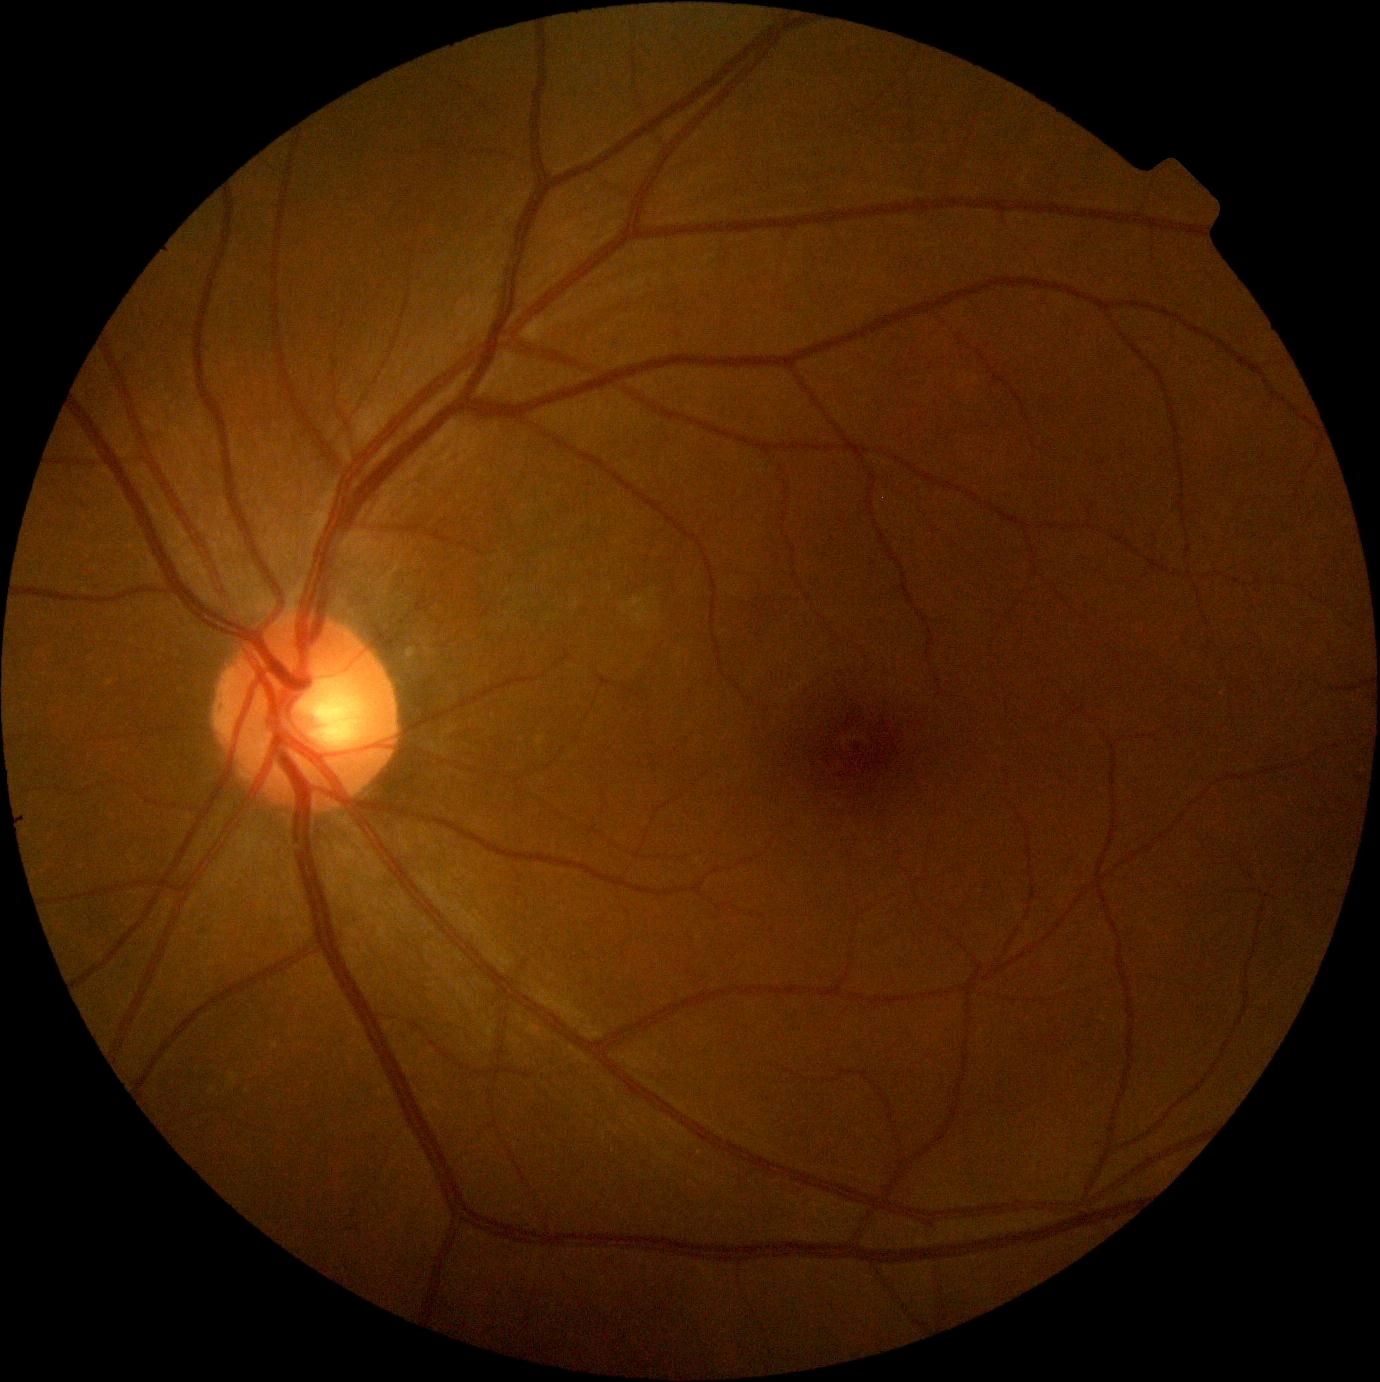
diabetic retinopathy grade = no apparent diabetic retinopathy (0); DR impression = no signs of DR.